640 x 480 pixels · wide-field fundus photograph from neonatal ROP screening.
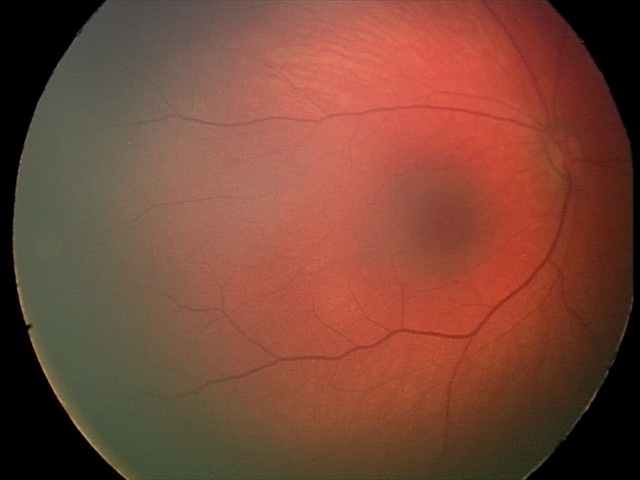 Impression = no abnormalities